Infant wide-field fundus photograph
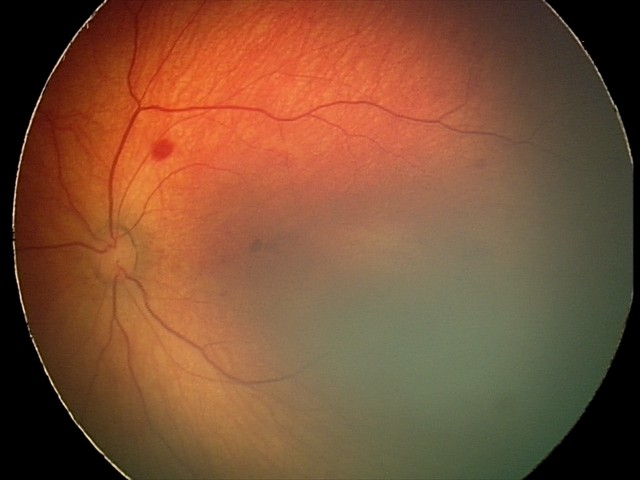 Assessment: retinal hemorrhages.